50° FOV · captured after pupil dilation
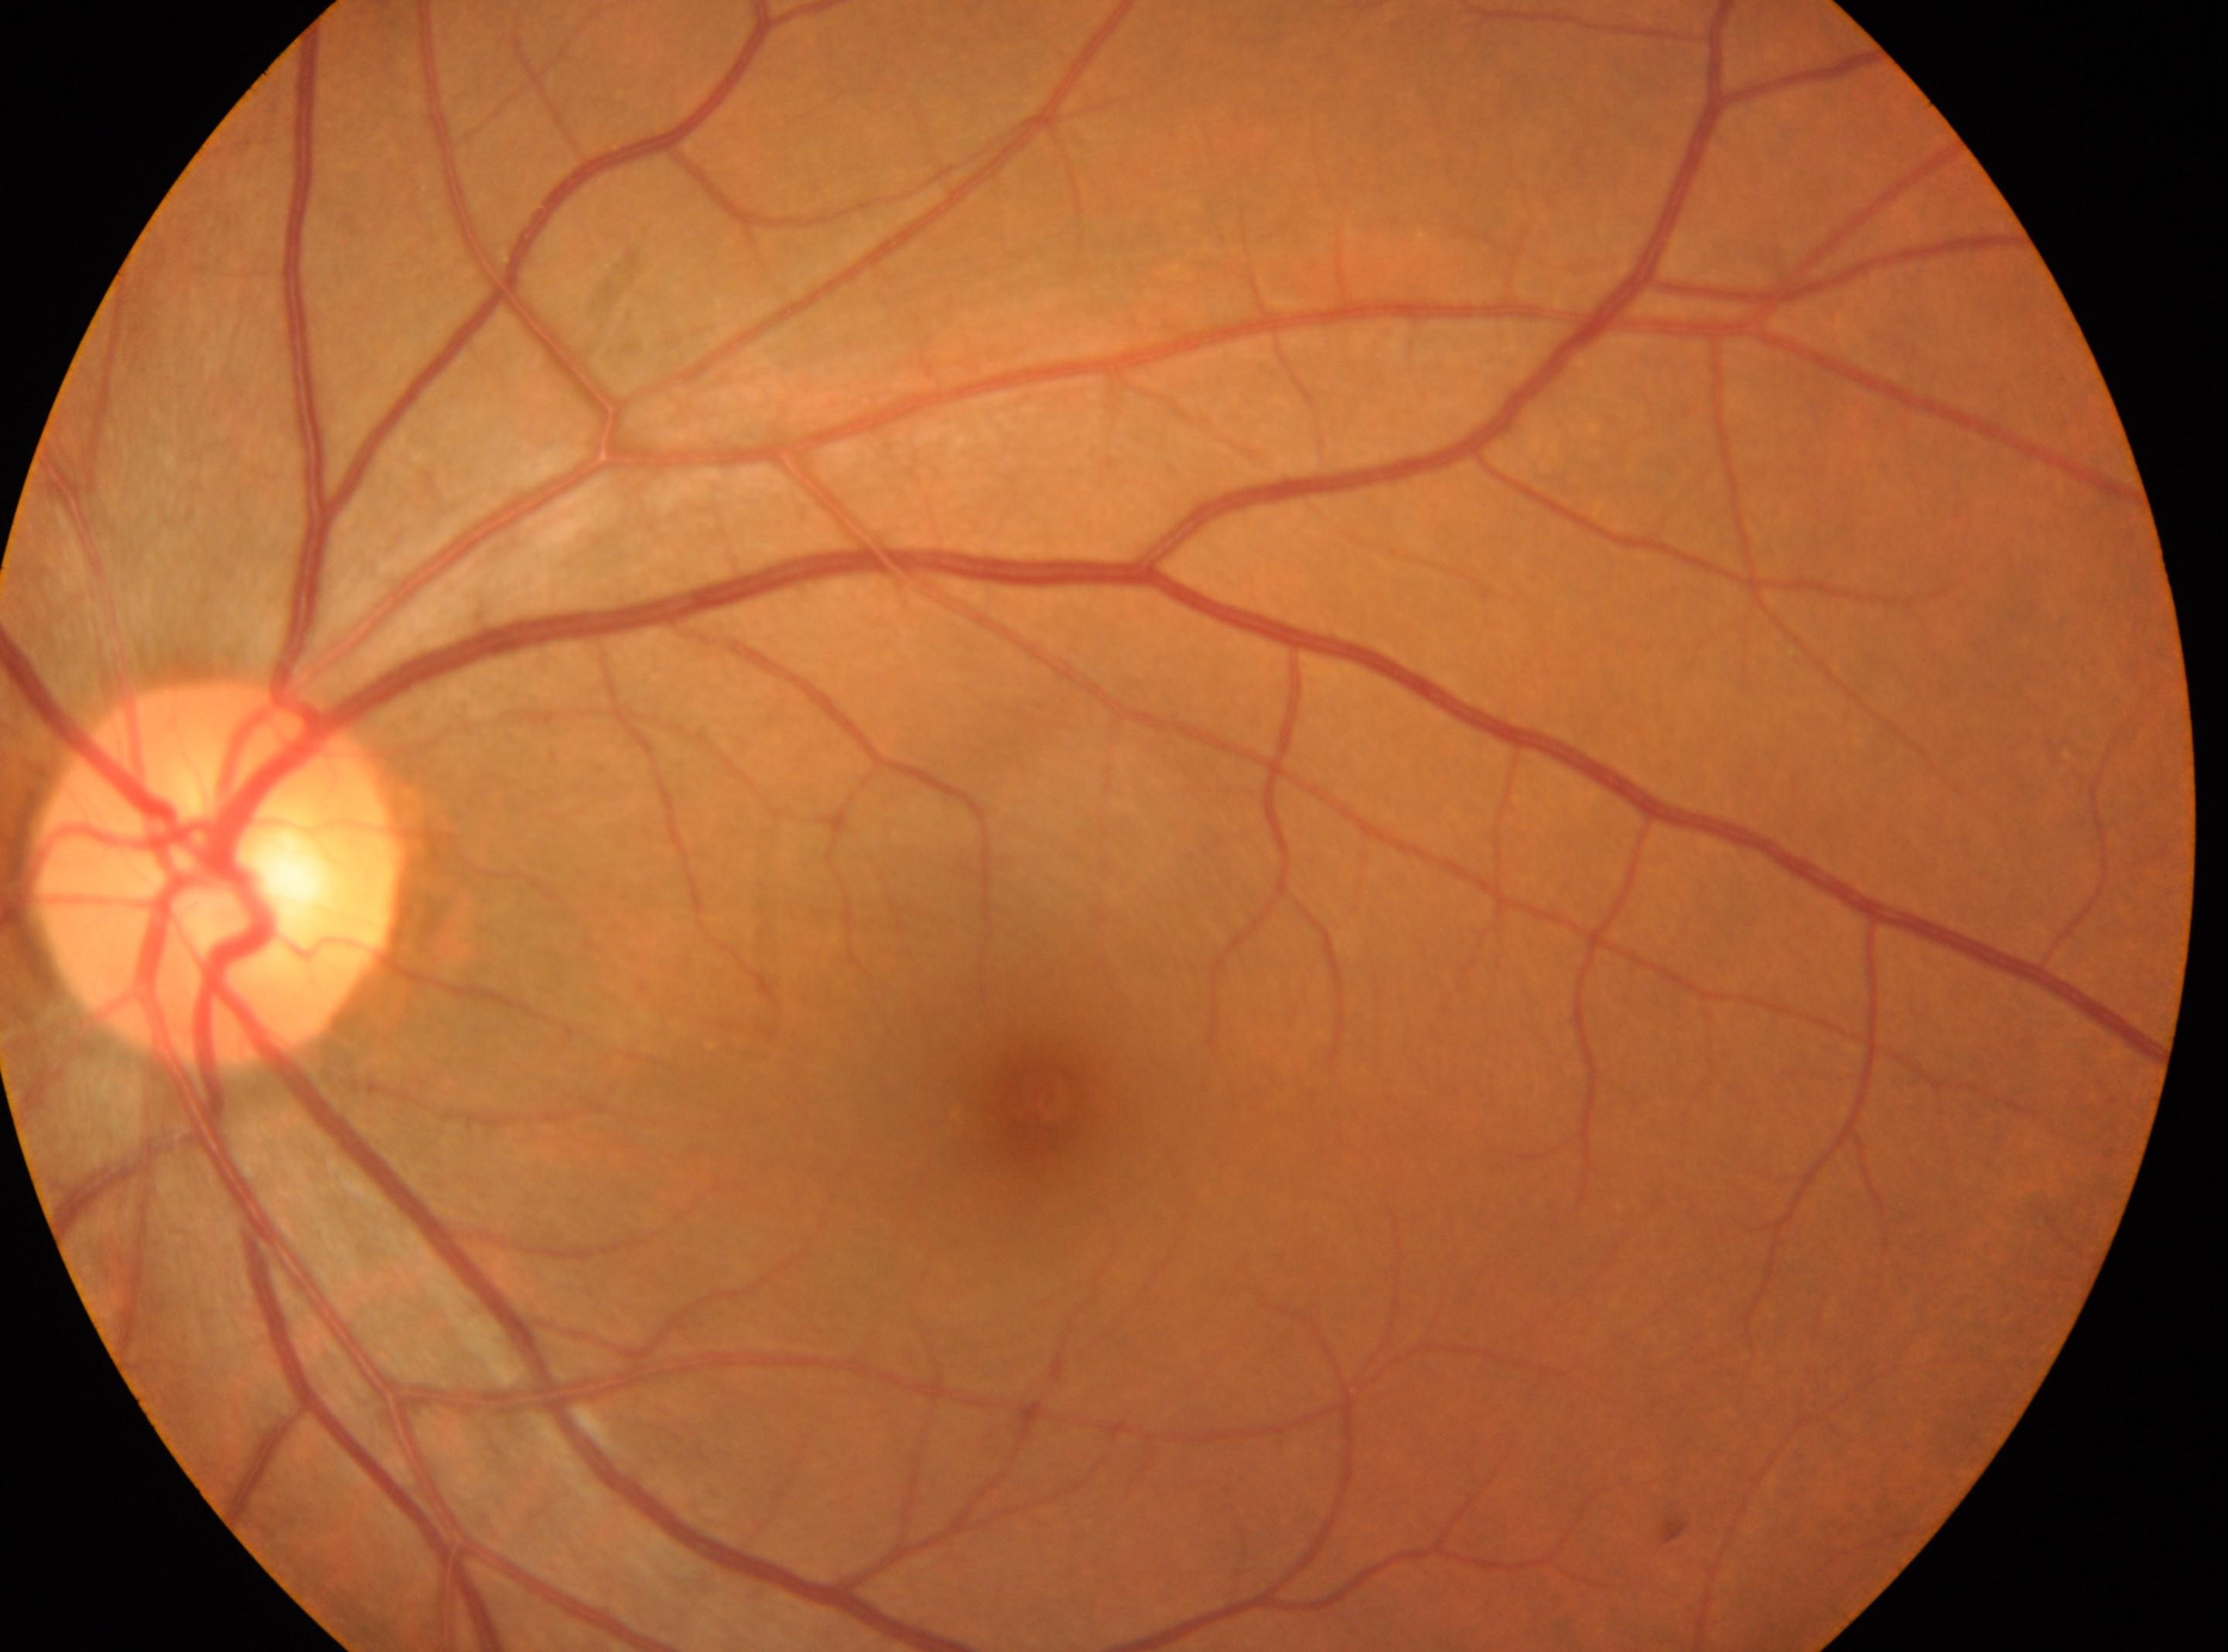 The fovea is at (x: 1046, y: 1100).
The optic disk is at (x: 216, y: 869).
This is the left eye.
Diabetic retinopathy severity: 0/4 — no visible signs of diabetic retinopathy.